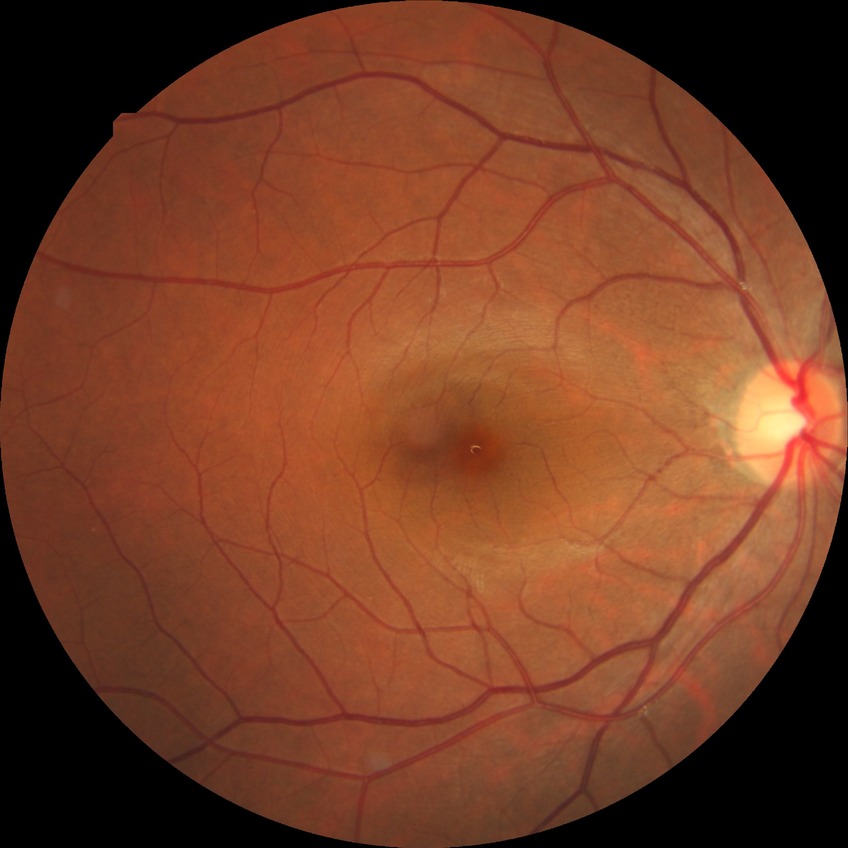 Davis grading: no diabetic retinopathy.